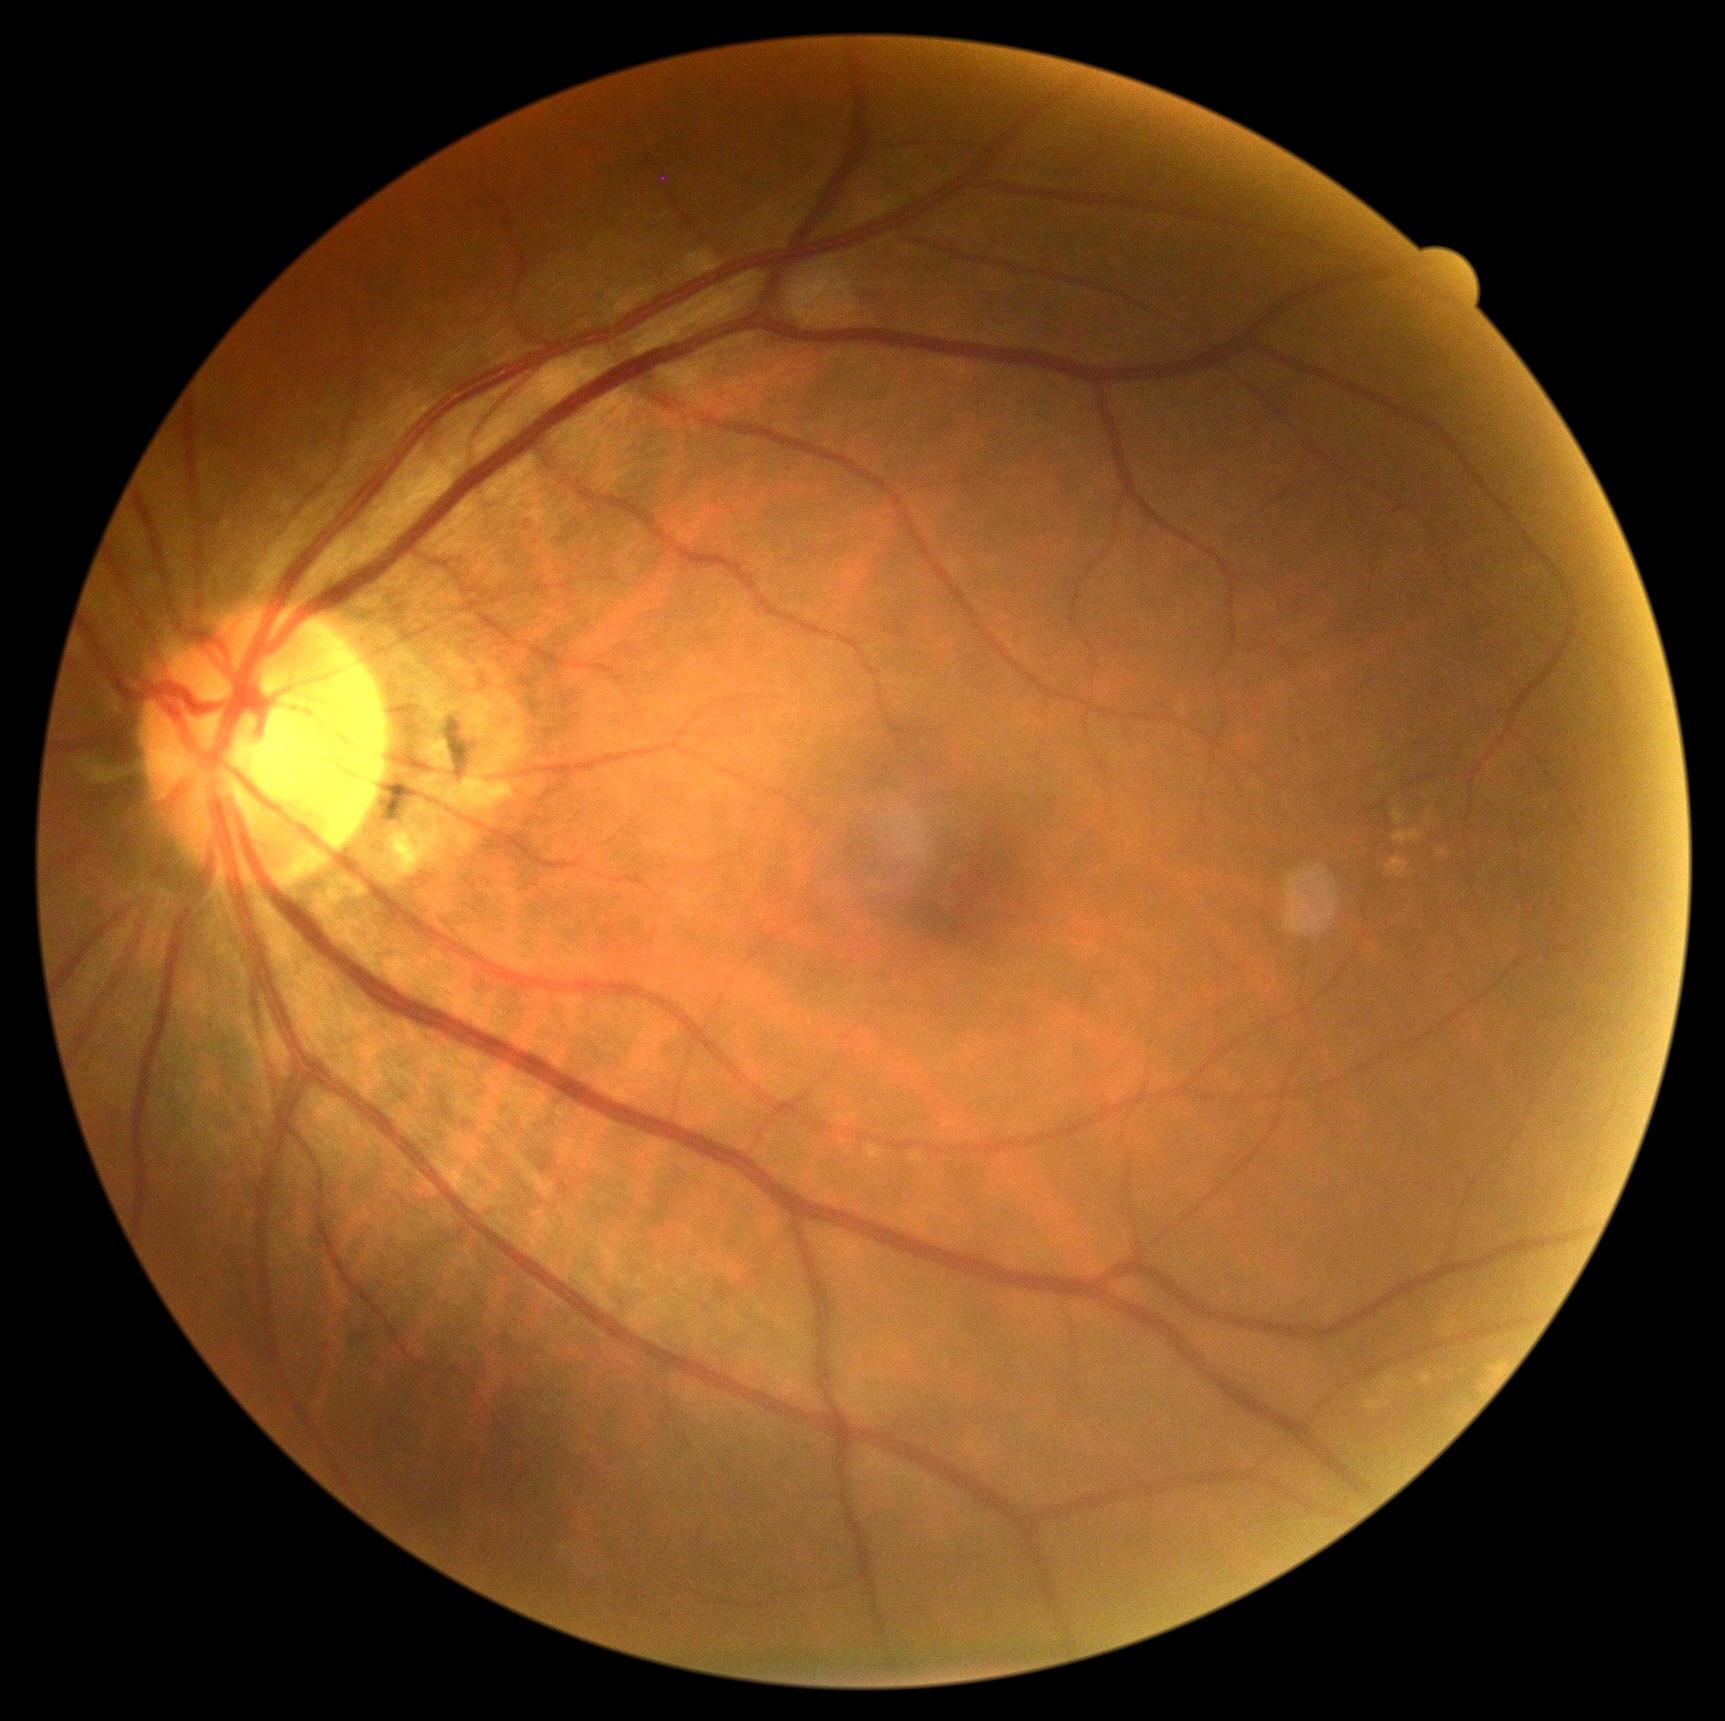 Findings:
- diabetic retinopathy — grade 0
- DR impression — no DR findings